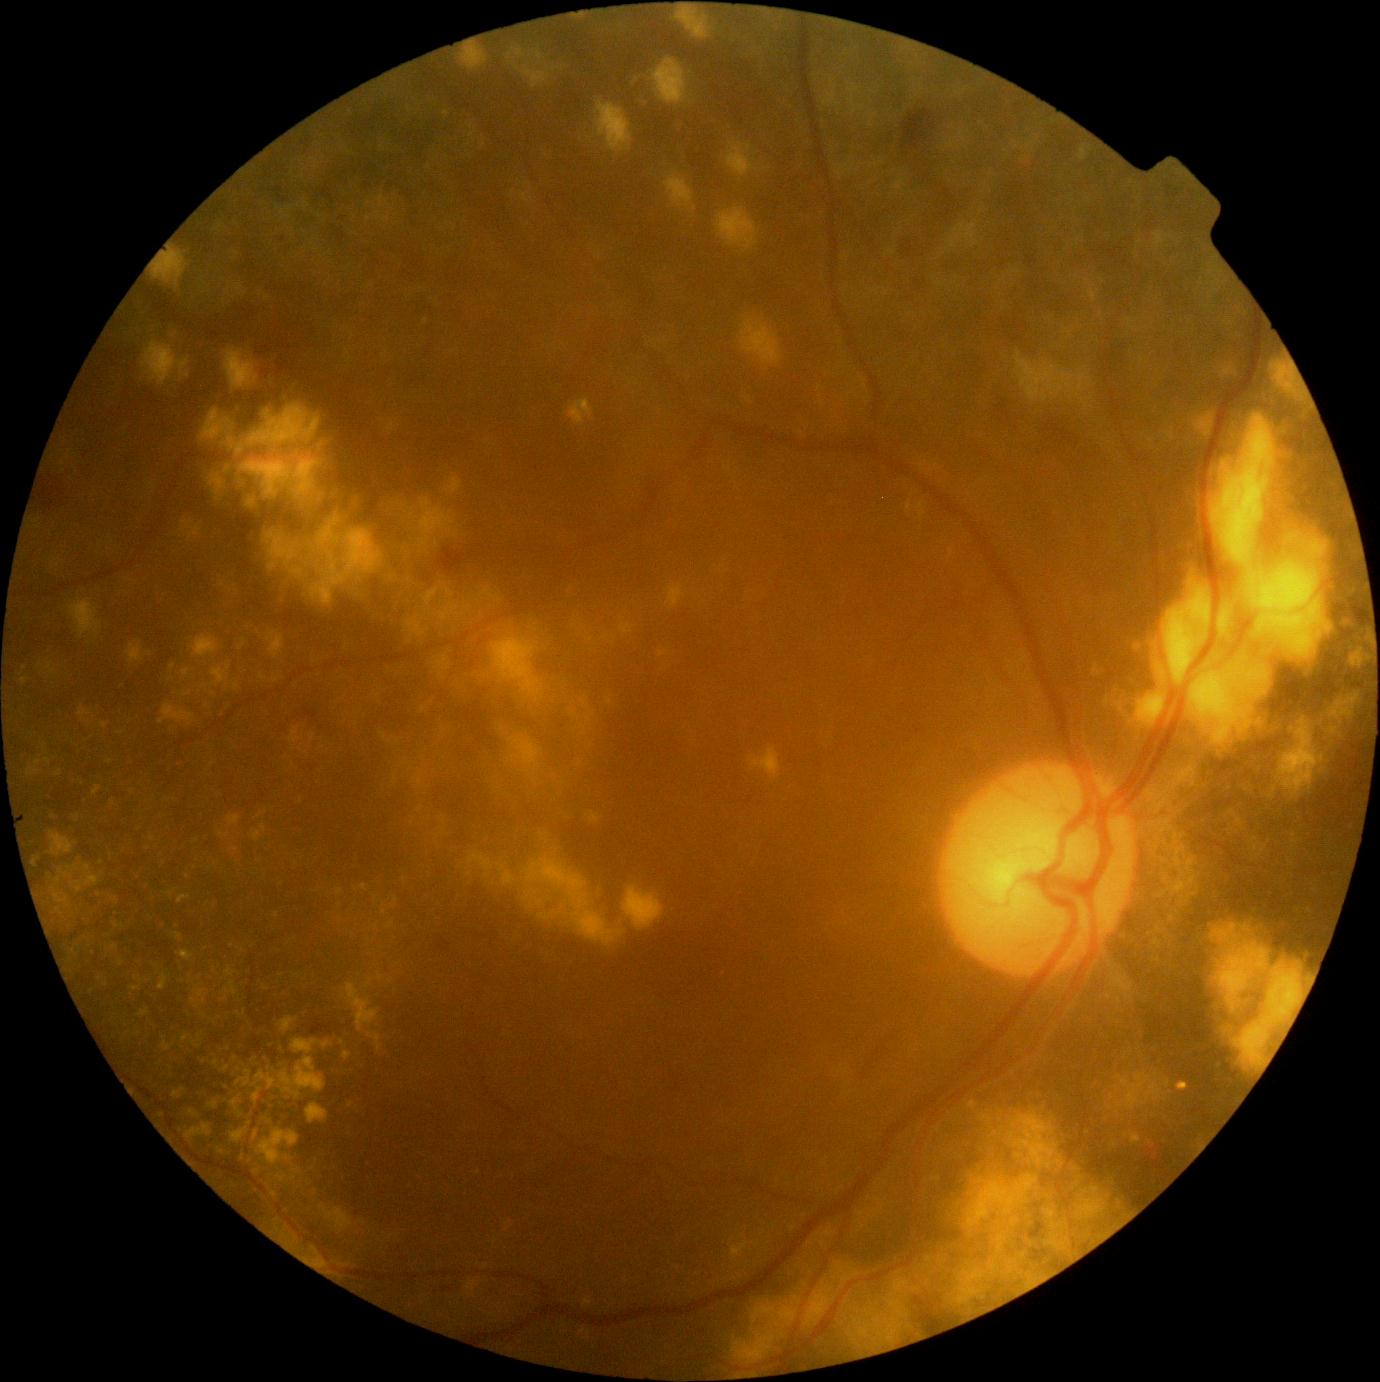 DR grade: moderate non-proliferative diabetic retinopathy (2).